Acquired with a Remidio Fundus on Phone — 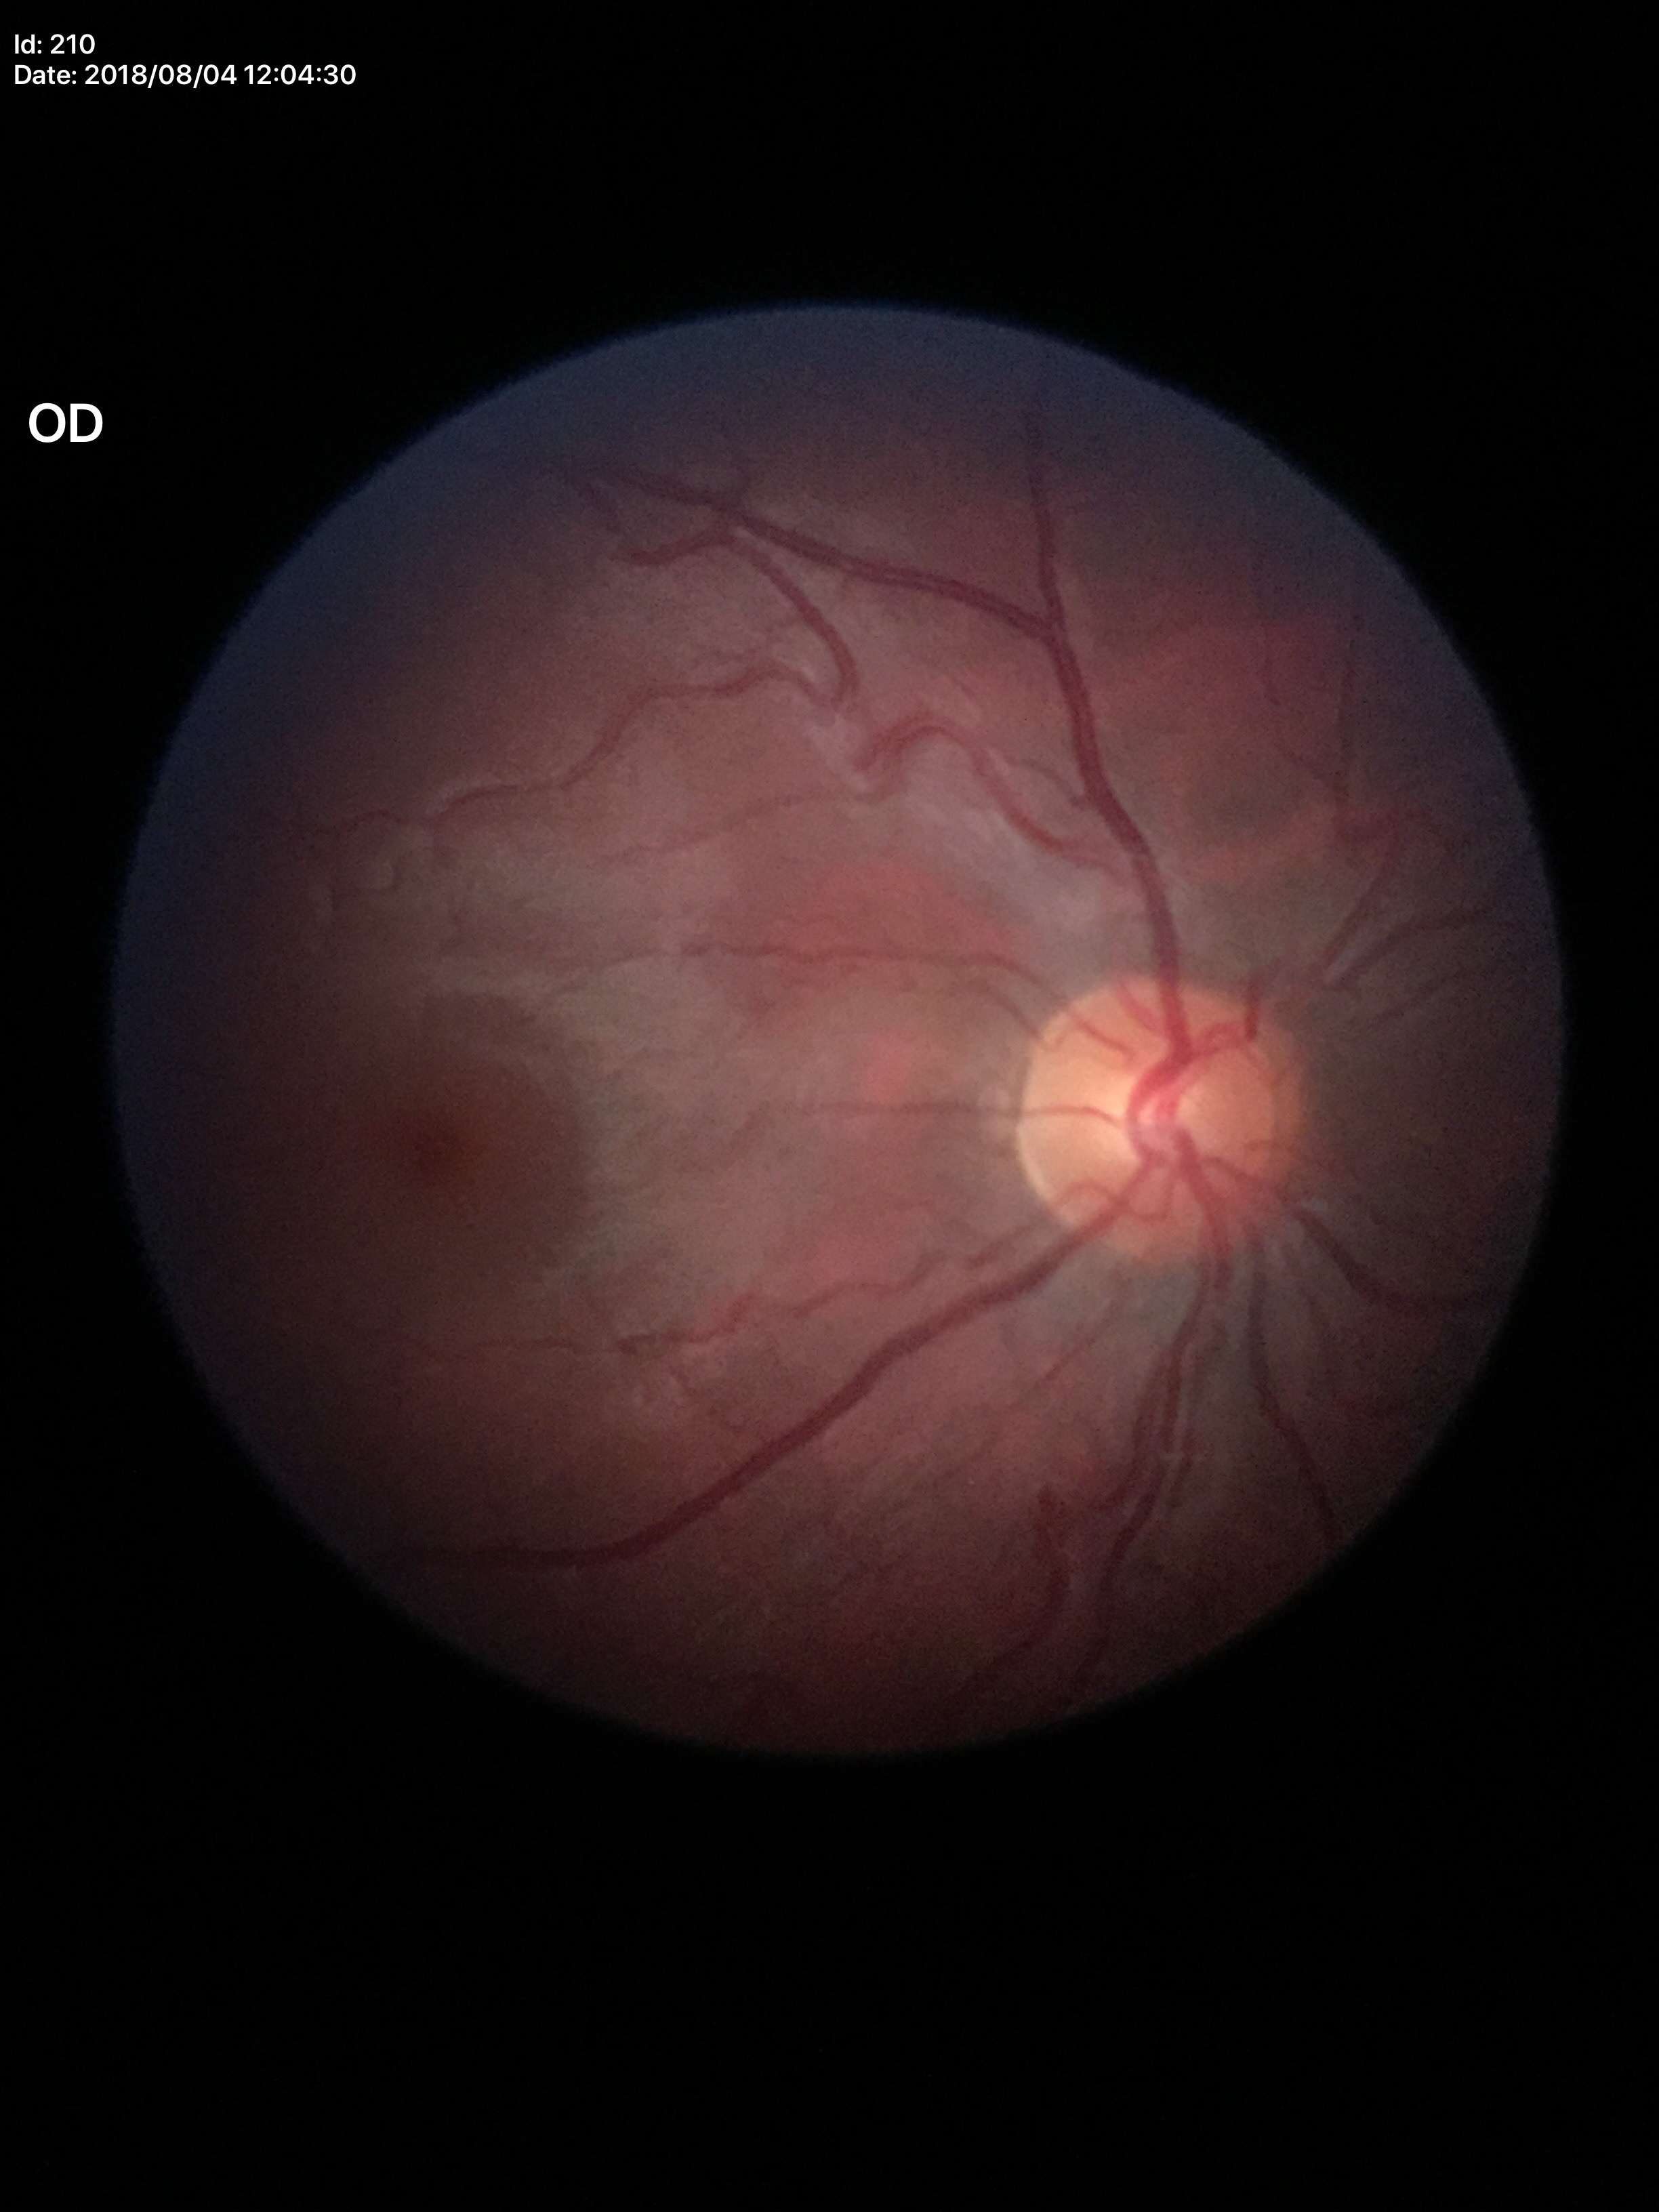 Glaucoma screening impression: no suspicious findings.
Horizontal CDR of 0.49.
Vertical CDR is 0.49.